Graded on the modified Davis scale — 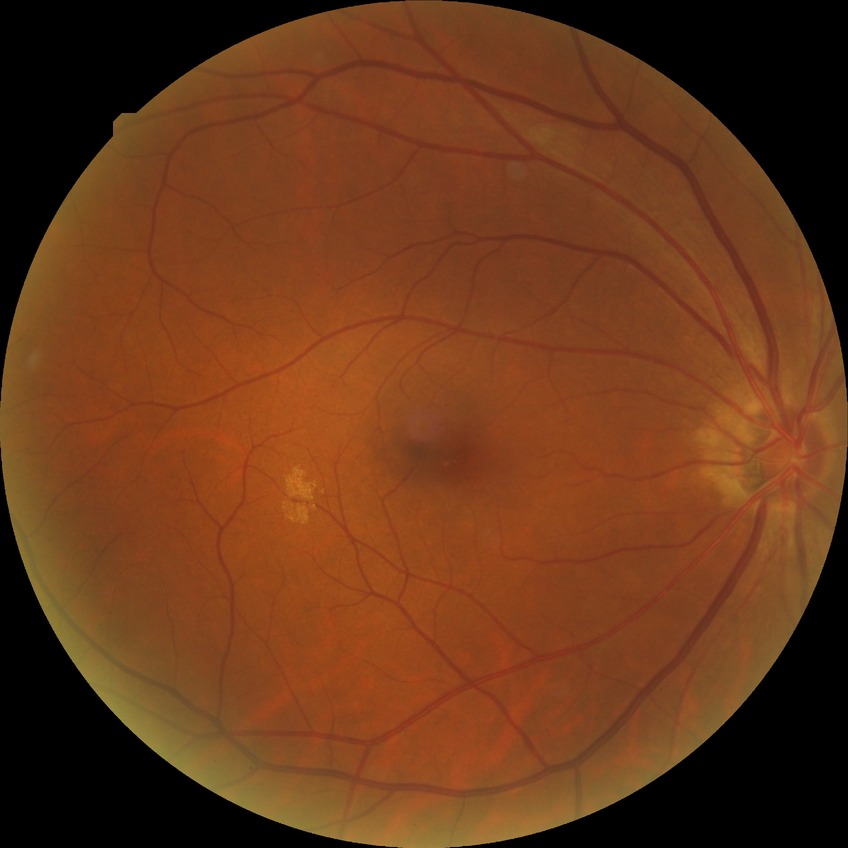

Diabetic retinopathy (DR): simple diabetic retinopathy (SDR). The retinopathy is classified as non-proliferative diabetic retinopathy.